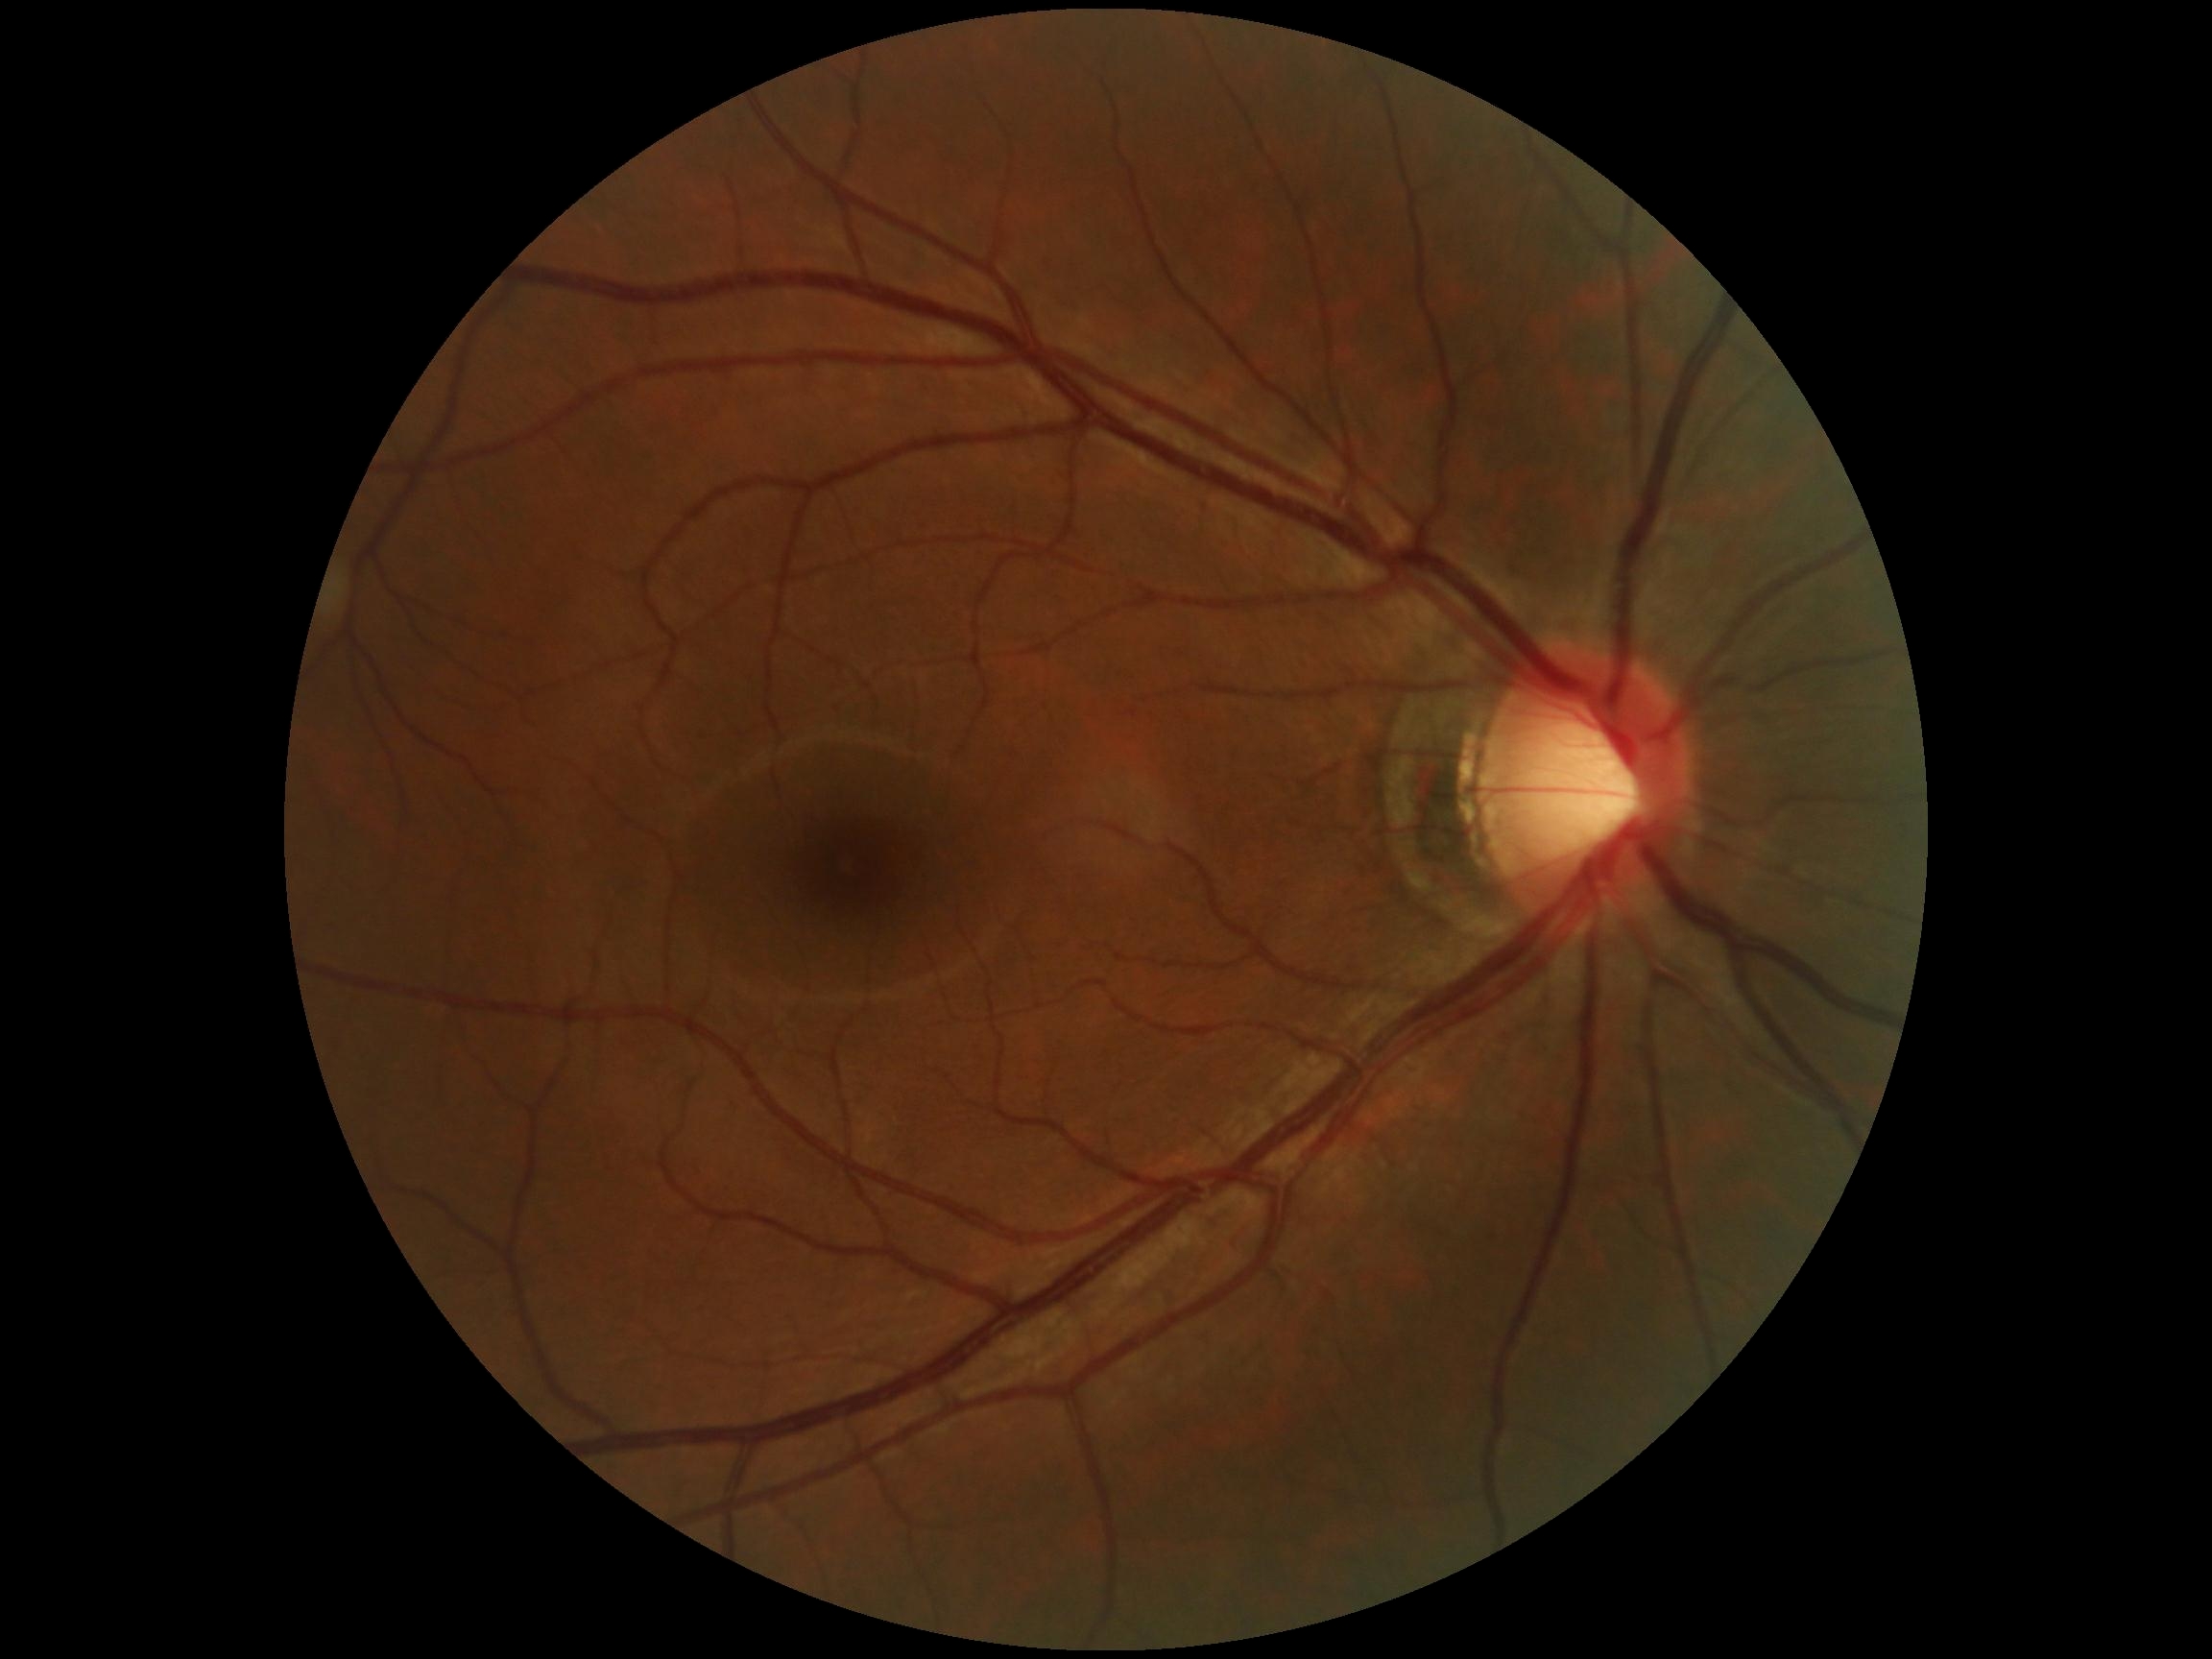
DR is no apparent diabetic retinopathy (grade 0). No apparent diabetic retinopathy.